DR severity per modified Davis staging, color fundus image — 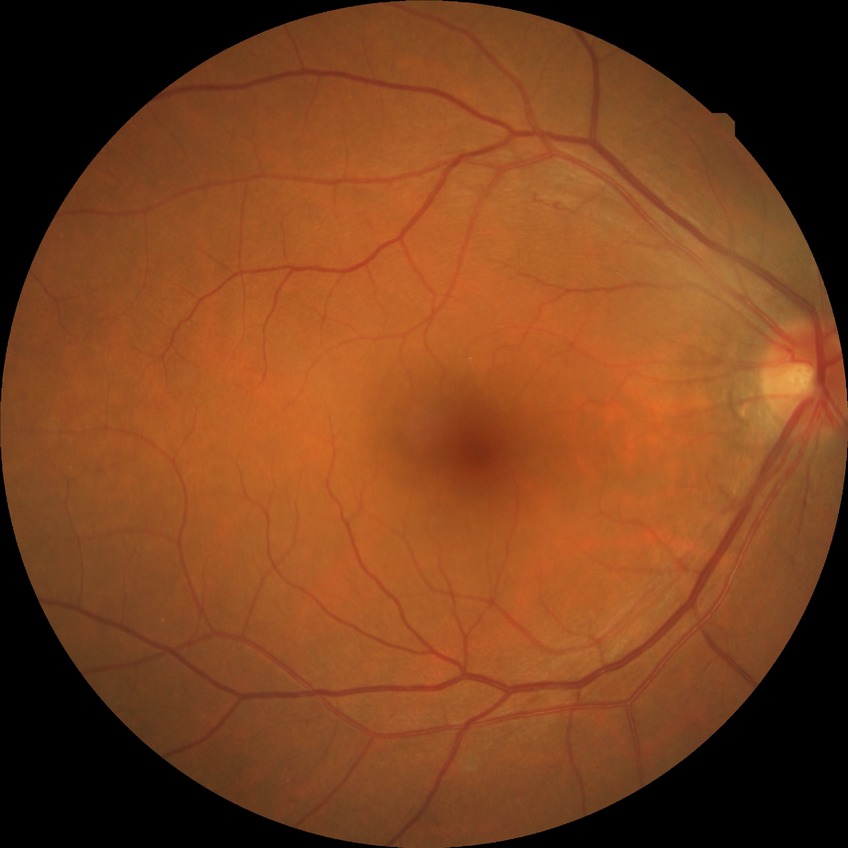 Diabetic retinopathy (DR) is NDR (no diabetic retinopathy).